45-degree field of view; color fundus photograph; 2212x1672px: 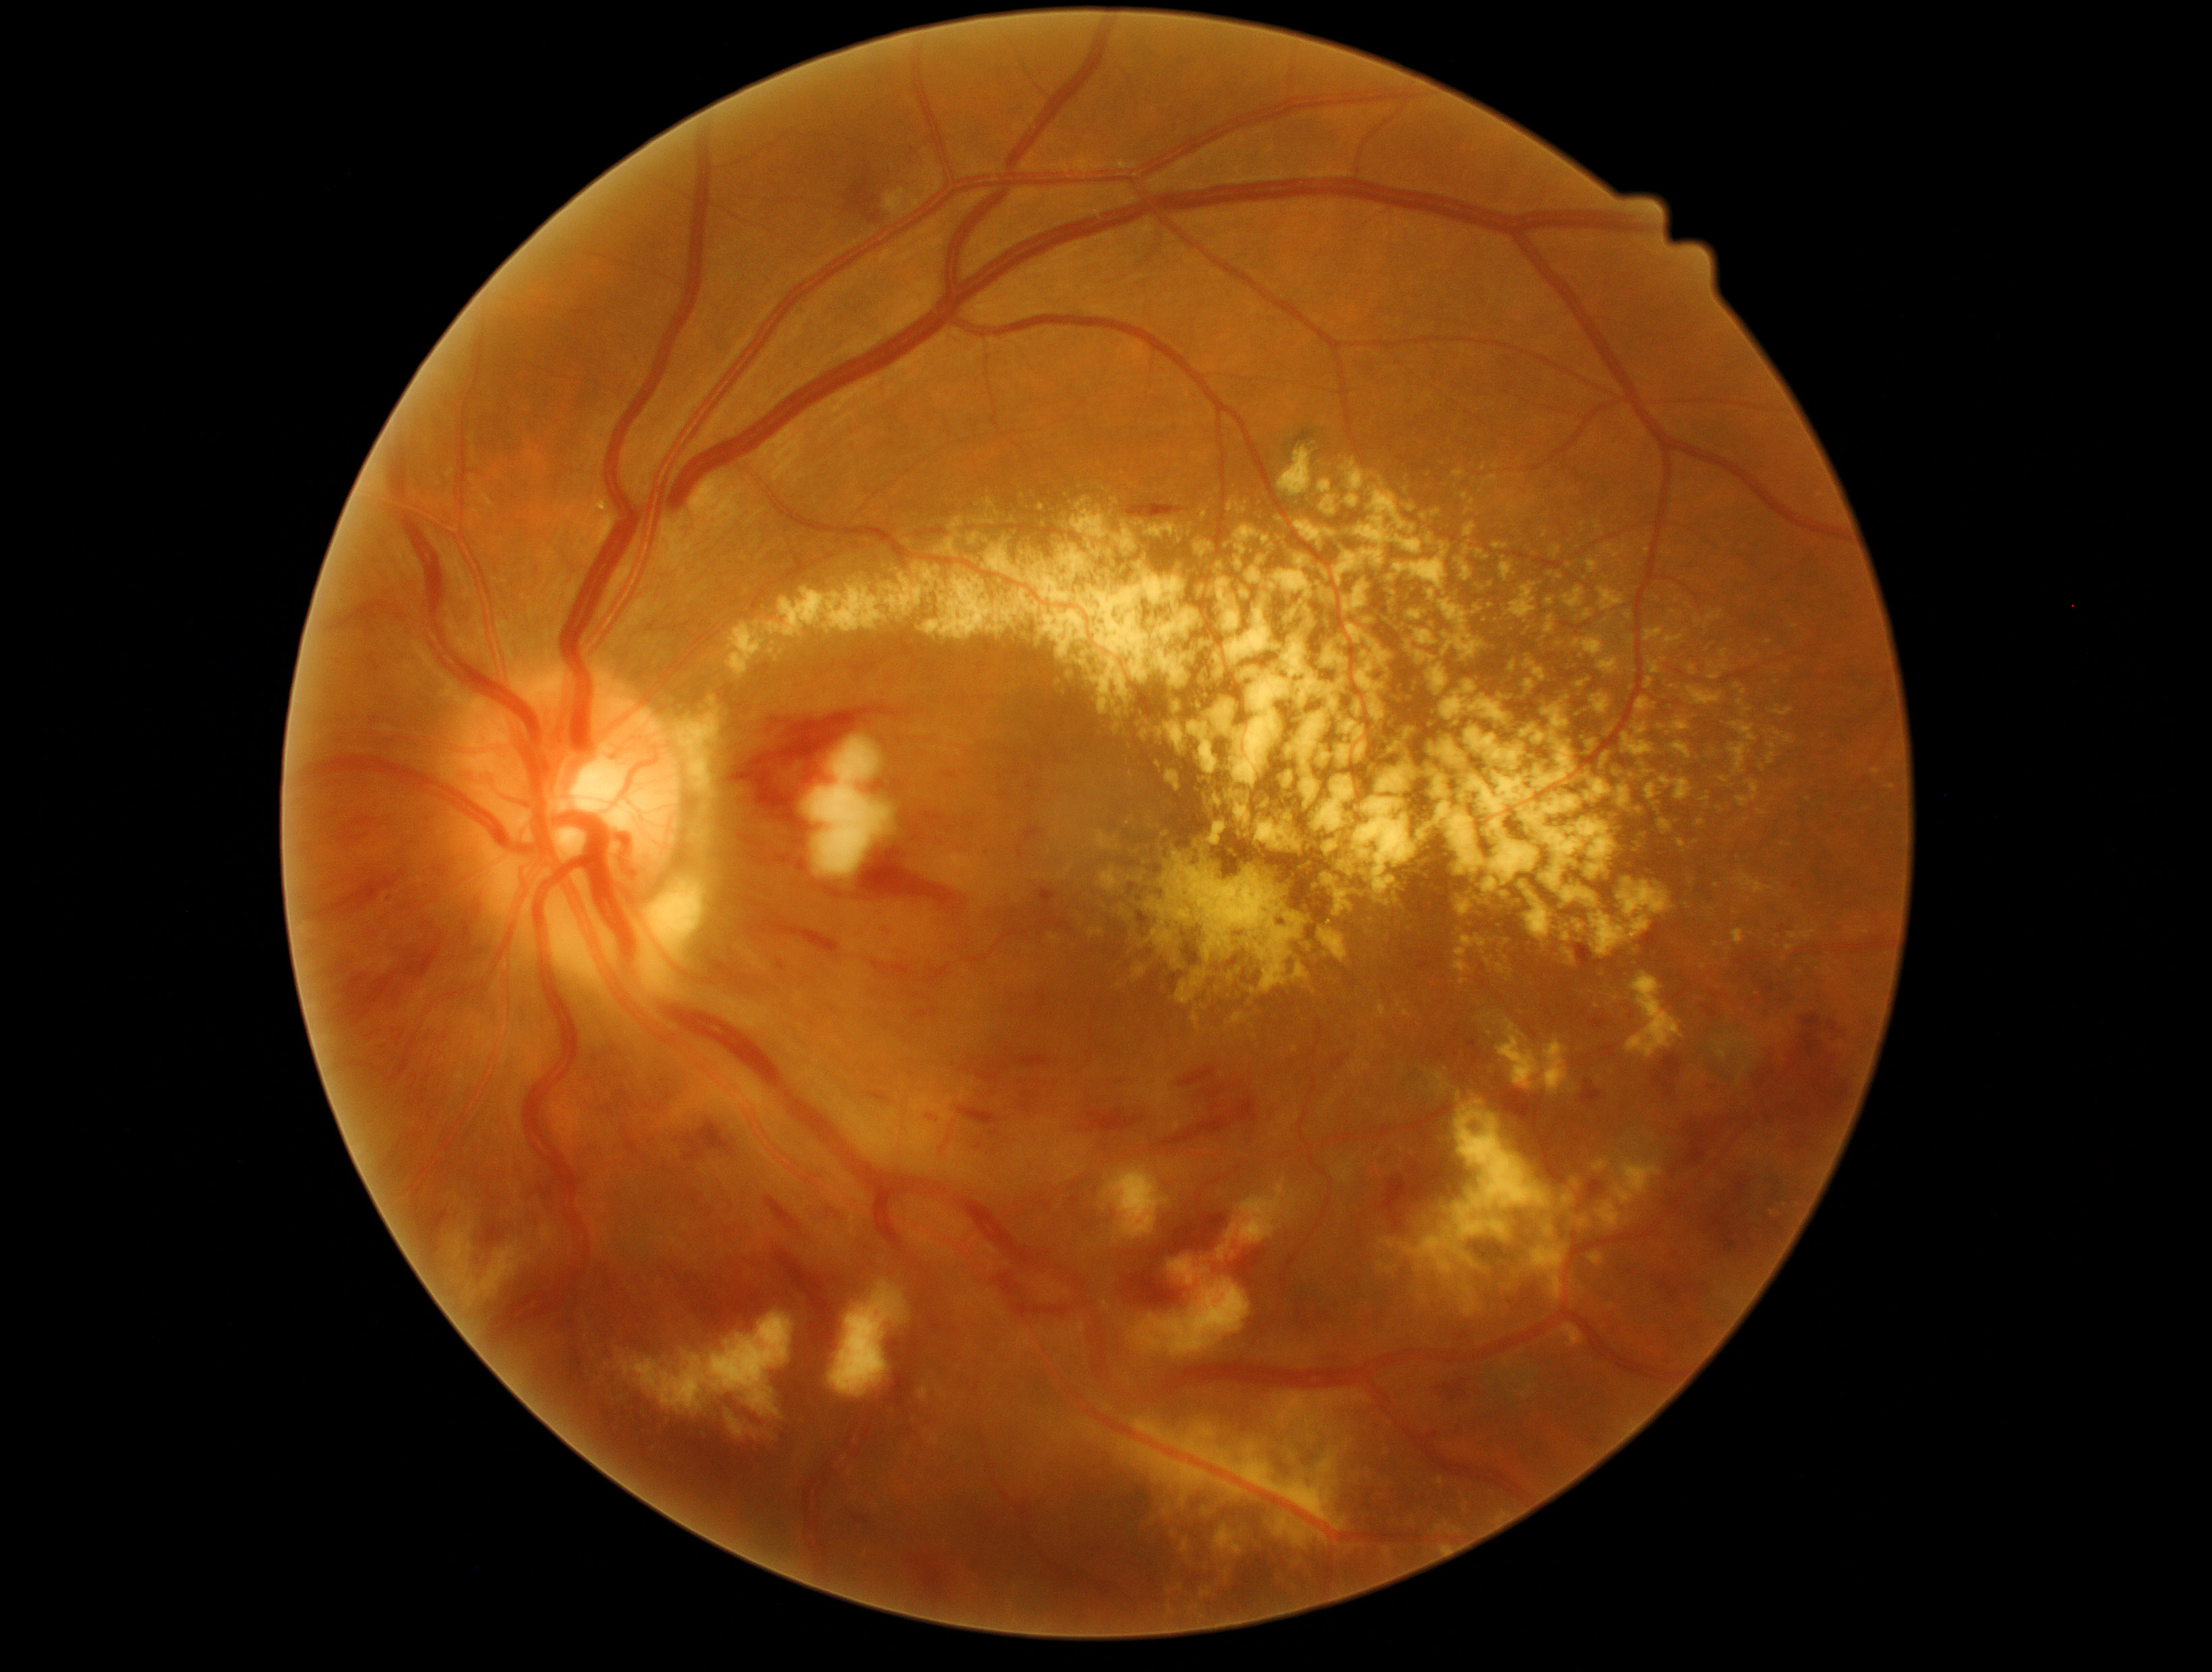

Diabetic retinopathy grade: 3
Selected lesions:
hemorrhages (partial): [x1=1599, y1=1046, x2=1615, y2=1055]; [x1=365, y1=1029, x2=382, y2=1042]; [x1=867, y1=1090, x2=892, y2=1106]; [x1=1078, y1=1110, x2=1146, y2=1133]; [x1=390, y1=1131, x2=421, y2=1167]; [x1=1031, y1=1194, x2=1053, y2=1210]; [x1=320, y1=870, x2=408, y2=918]; [x1=1792, y1=1132, x2=1807, y2=1151]; [x1=1034, y1=888, x2=1070, y2=939]; [x1=1796, y1=1012, x2=1823, y2=1059]; [x1=392, y1=1028, x2=400, y2=1035]; [x1=407, y1=1085, x2=428, y2=1113]; [x1=1452, y1=1028, x2=1476, y2=1050]; [x1=608, y1=1104, x2=616, y2=1116]; [x1=992, y1=1272, x2=1024, y2=1299]; [x1=674, y1=1255, x2=784, y2=1332]; [x1=338, y1=598, x2=407, y2=636]
Smaller hemorrhages around (x=595, y=1059)
hard exudates (partial): [x1=1088, y1=927, x2=1104, y2=939]; [x1=1438, y1=591, x2=1491, y2=661]; [x1=1197, y1=575, x2=1281, y2=695]; [x1=1584, y1=558, x2=1598, y2=579]; [x1=1561, y1=1323, x2=1584, y2=1349]; [x1=1517, y1=888, x2=1552, y2=946]; [x1=1638, y1=665, x2=1662, y2=696]; [x1=1429, y1=725, x2=1621, y2=912]; [x1=1788, y1=930, x2=1819, y2=942]; [x1=1308, y1=1433, x2=1317, y2=1442]; [x1=1715, y1=942, x2=1723, y2=947]; [x1=1623, y1=726, x2=1656, y2=756]; [x1=1758, y1=810, x2=1766, y2=816]; [x1=1606, y1=549, x2=1621, y2=560]; [x1=1501, y1=558, x2=1511, y2=580]; [x1=1165, y1=769, x2=1184, y2=795]; [x1=1122, y1=912, x2=1148, y2=963]; [x1=1304, y1=865, x2=1313, y2=877]
Smaller hard exudates around (x=977, y=522); (x=1384, y=1047)